2228x1652px. CFP. Posterior pole field covering the optic disc and macula: 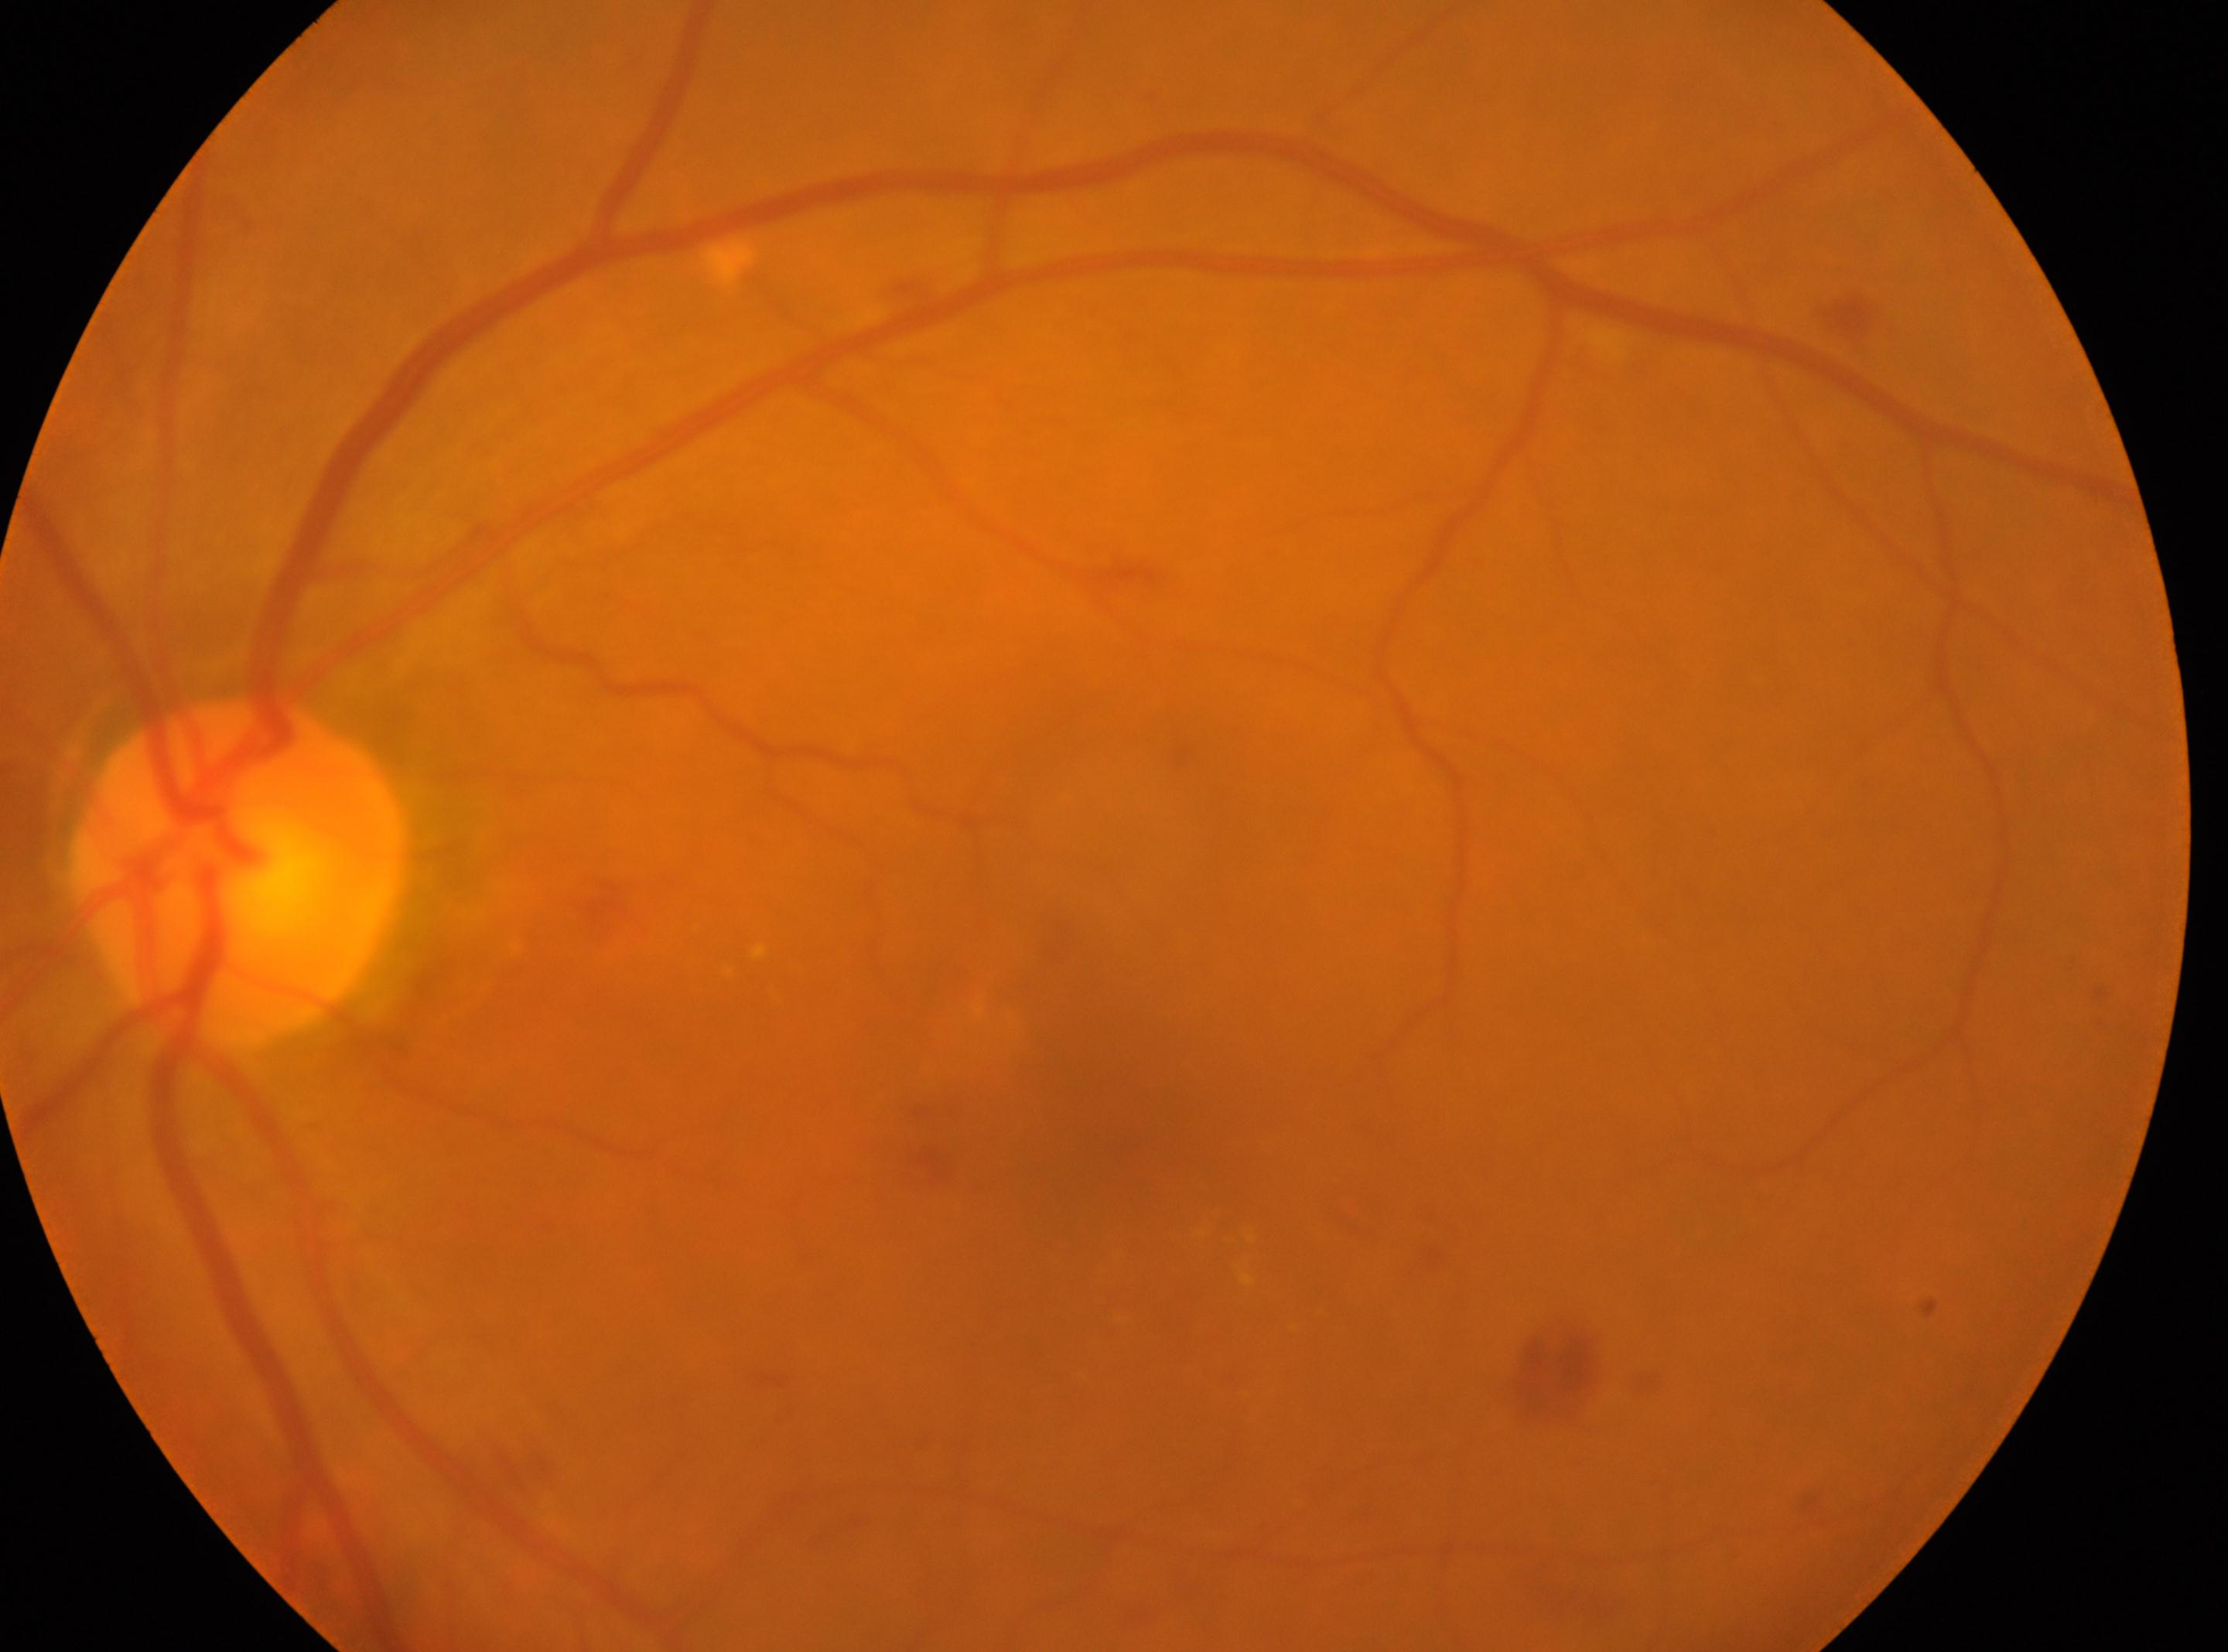

{
  "dr_grade": "2/4",
  "optic_disc": "(x: 242, y: 873)",
  "eye": "the left eye",
  "fovea": "(x: 1072, y: 1125)"
}